Optic nerve head photograph.
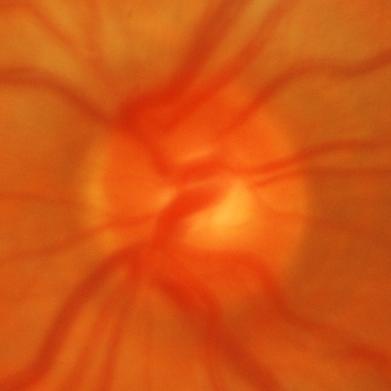
Glaucomatous optic neuropathy is present. Diagnosis = glaucomatous changes.